Wide-field fundus photograph from neonatal ROP screening:
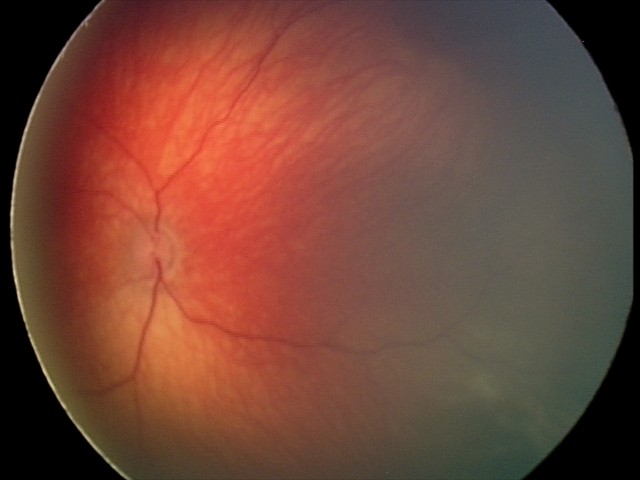
Screening examination consistent with retinal hemorrhages.